FOV: 50 degrees — 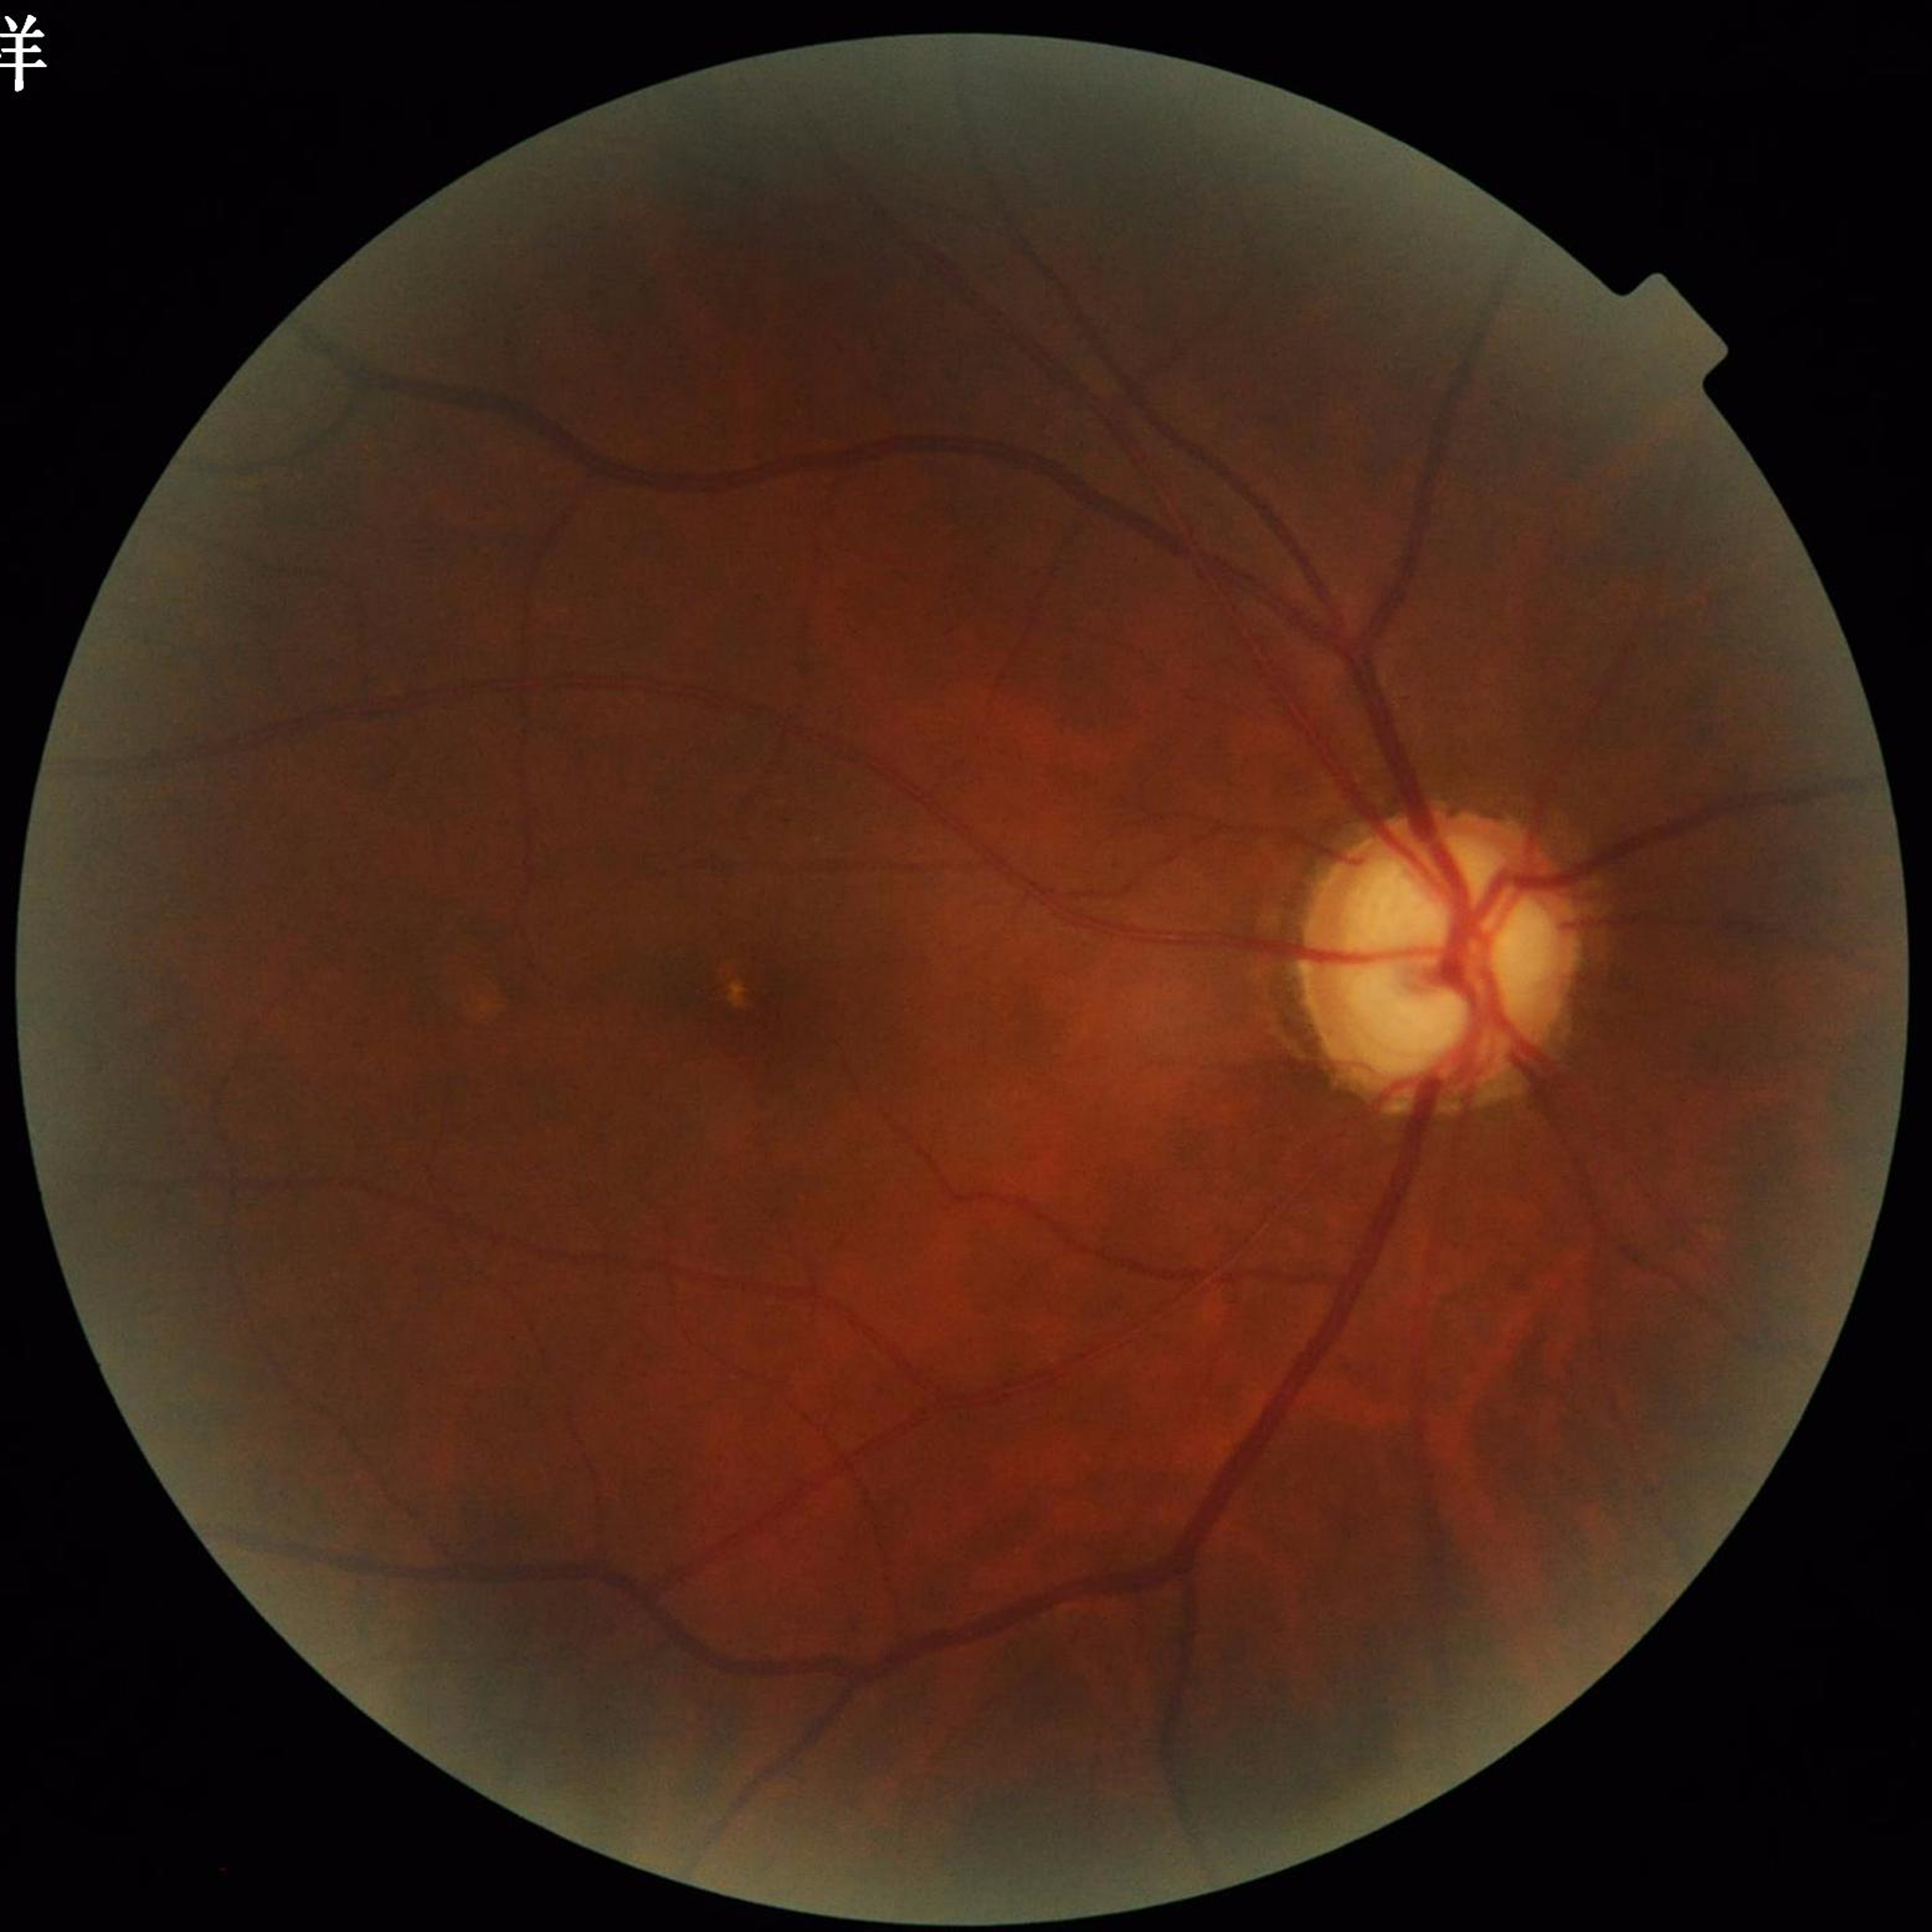
Impression: glaucoma; Photo quality: contrast adequate, no blur, illumination/color distortion present.